15-year-old patient; retinal fundus photograph; visual field mean deviation: -1.8 dB: 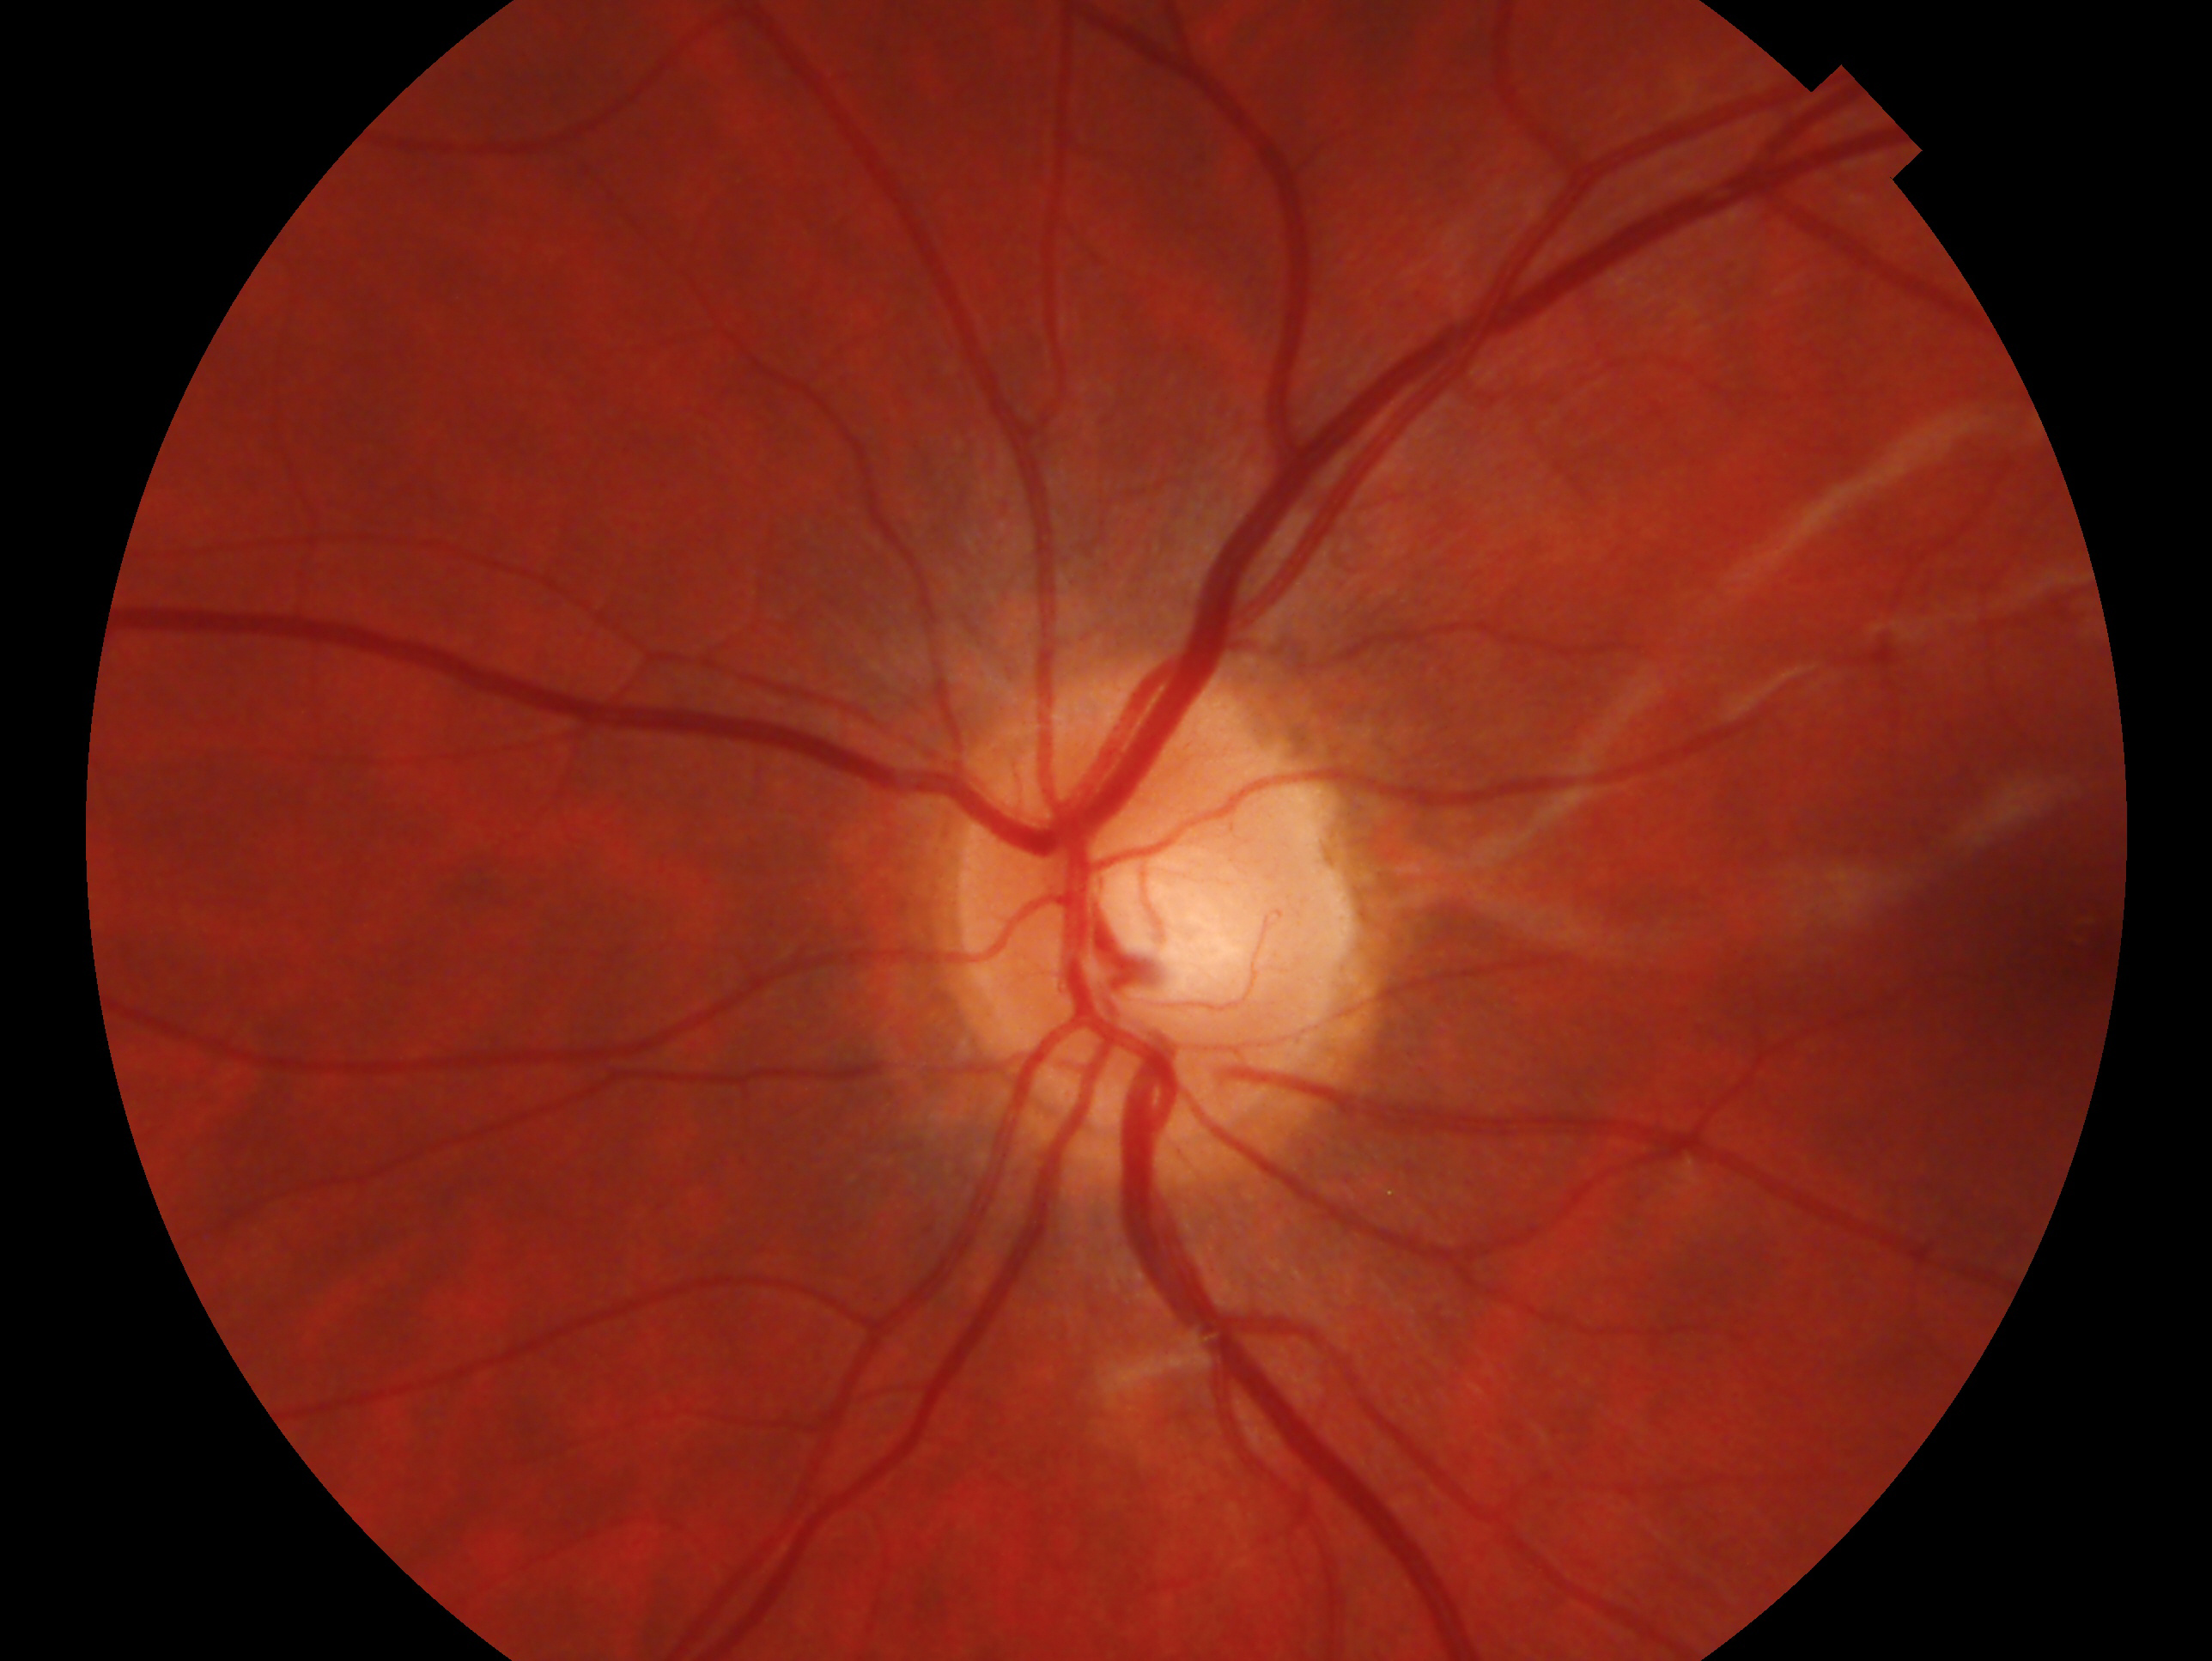
Annotations:
* laterality · left
* assessment · possible glaucoma